Camera: Phoenix ICON (100° FOV) · infant wide-field fundus photograph.
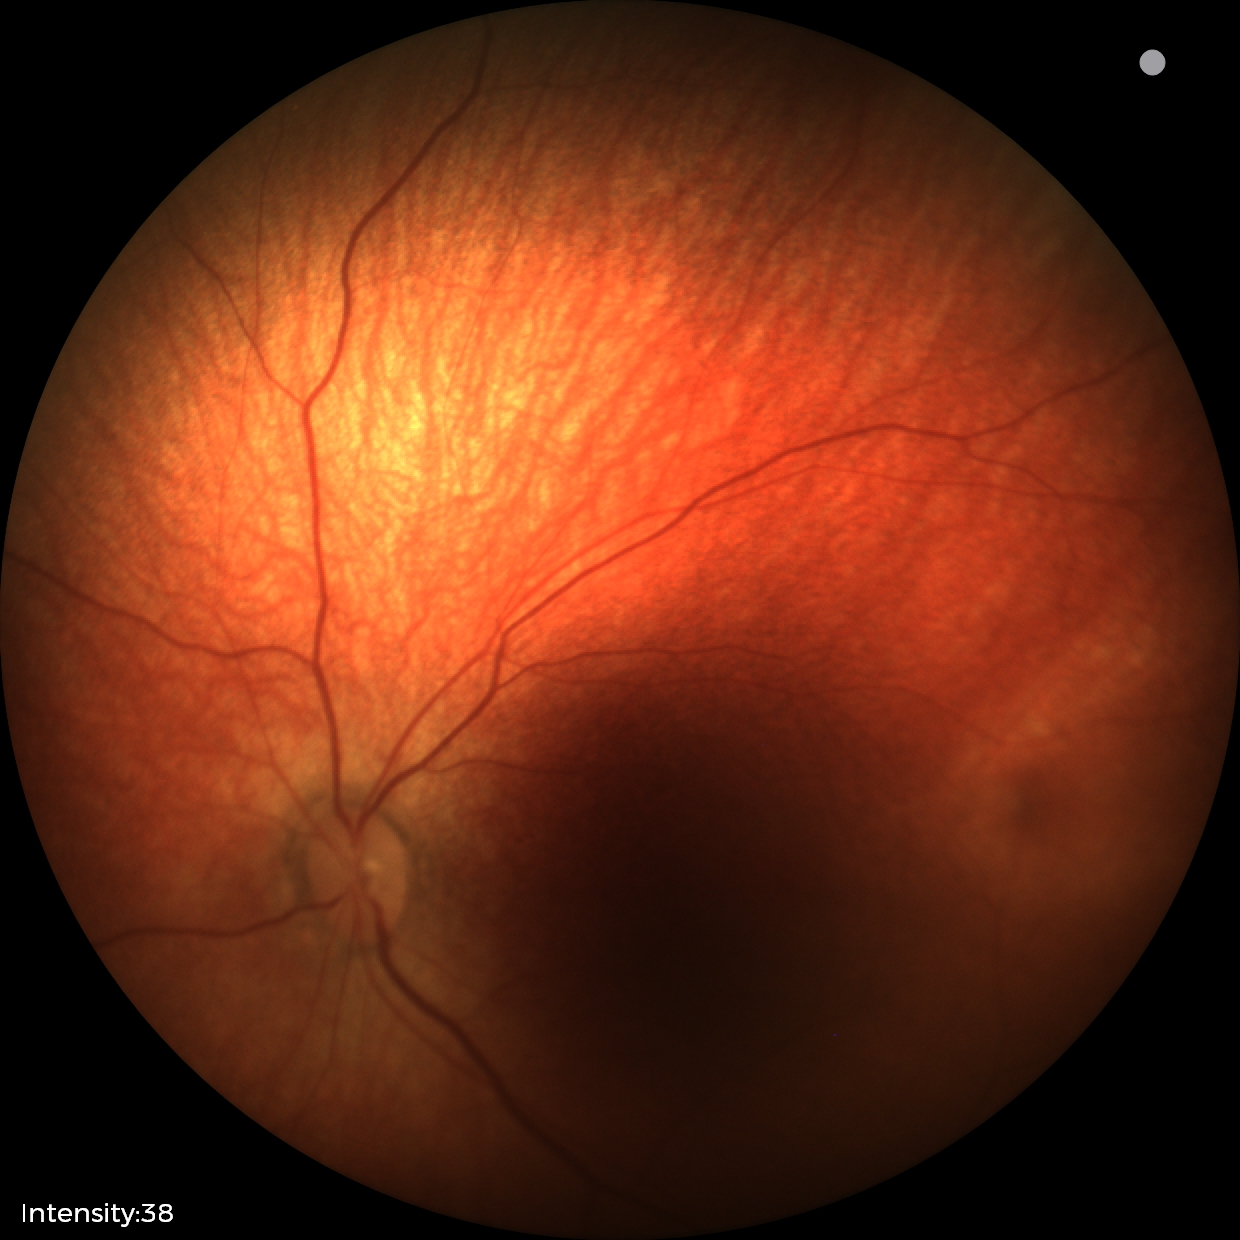
Examination with physiological retinal findings.